2352x1568px. FOV: 45 degrees. Color fundus photograph.
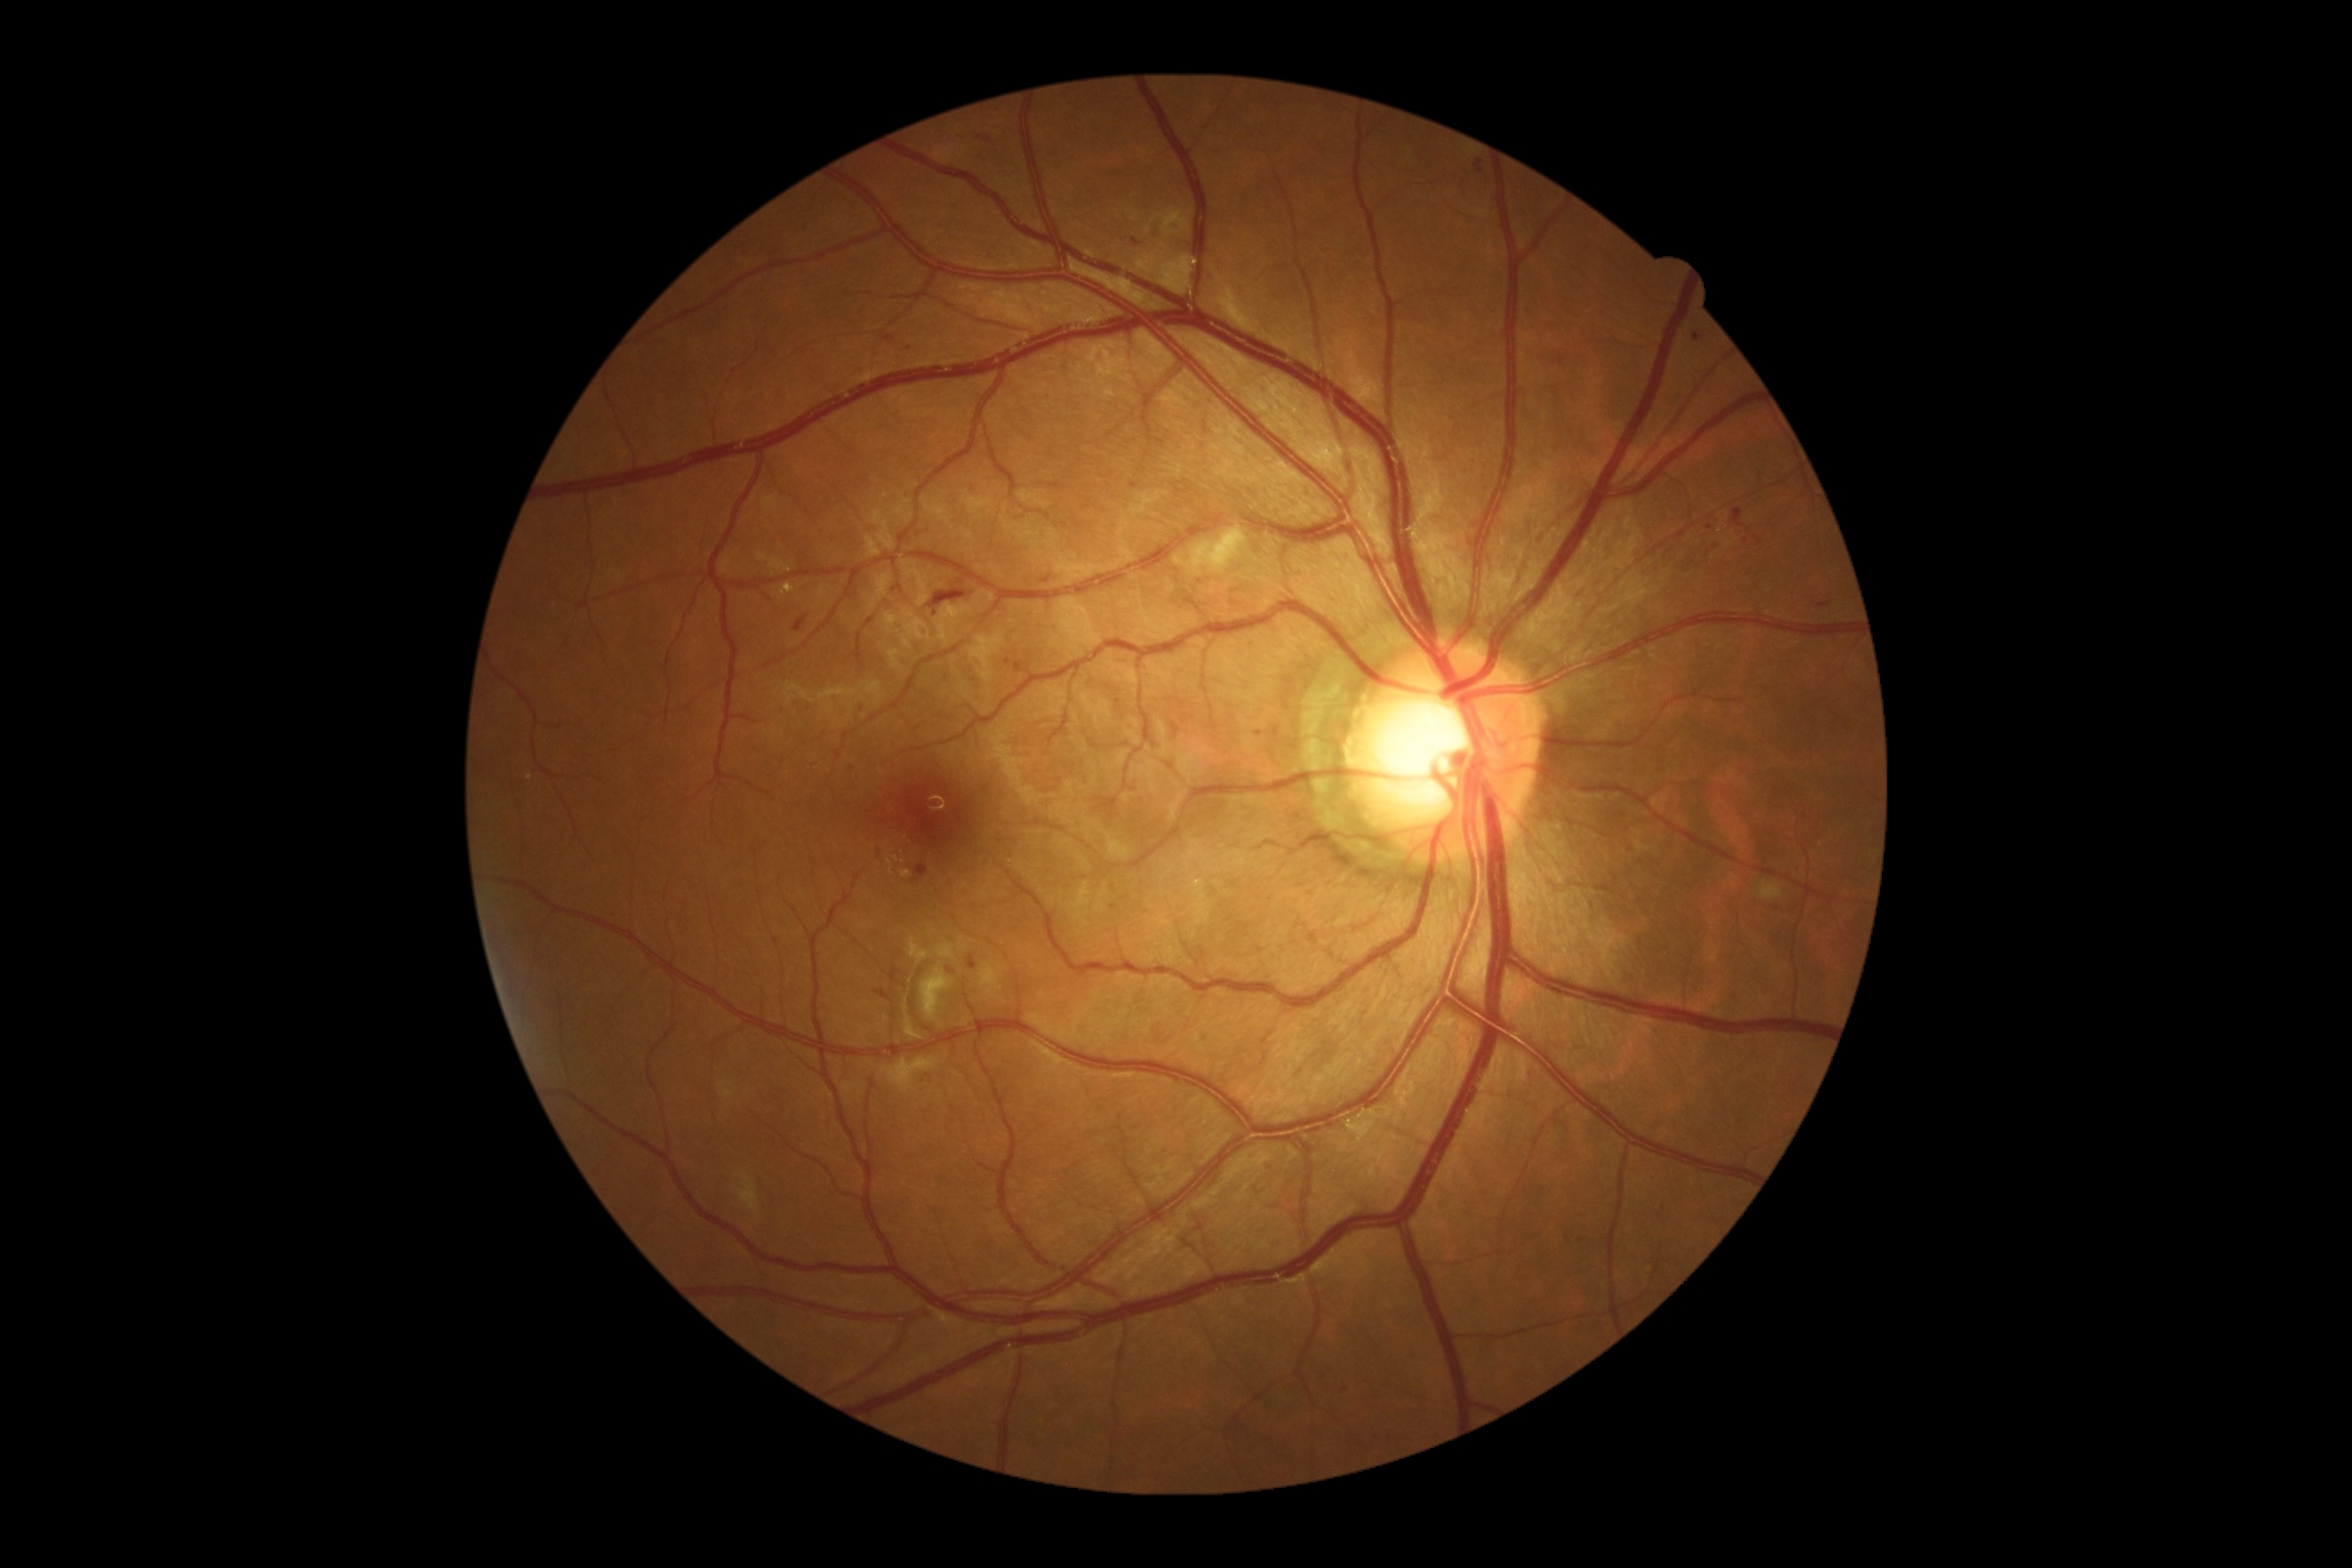 diabetic retinopathy grade@2 — more than just microaneurysms but less than severe NPDR.